848x848:
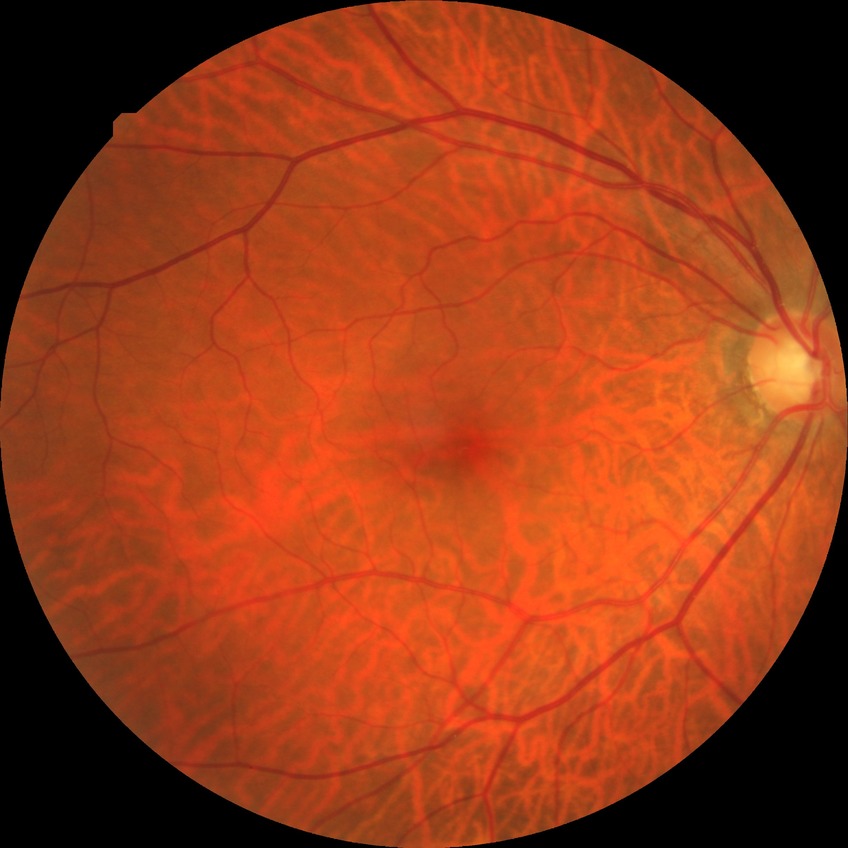 Diabetic retinopathy (DR) is no diabetic retinopathy (NDR).